Wide-field contact fundus photograph of an infant · 640 by 480 pixels — 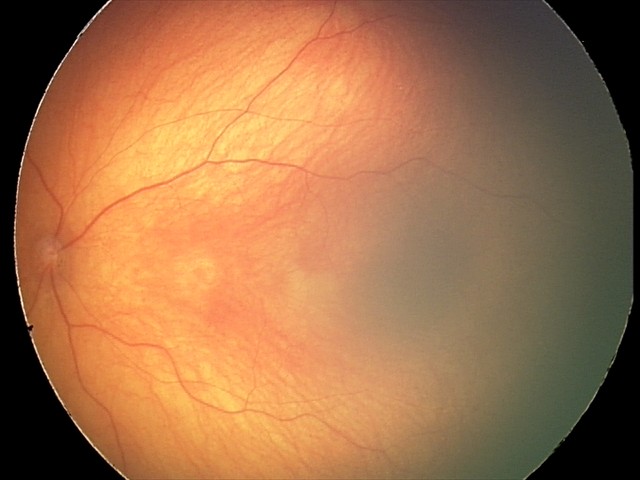 Screening examination diagnosed as physiological.